Modified Davis grading: 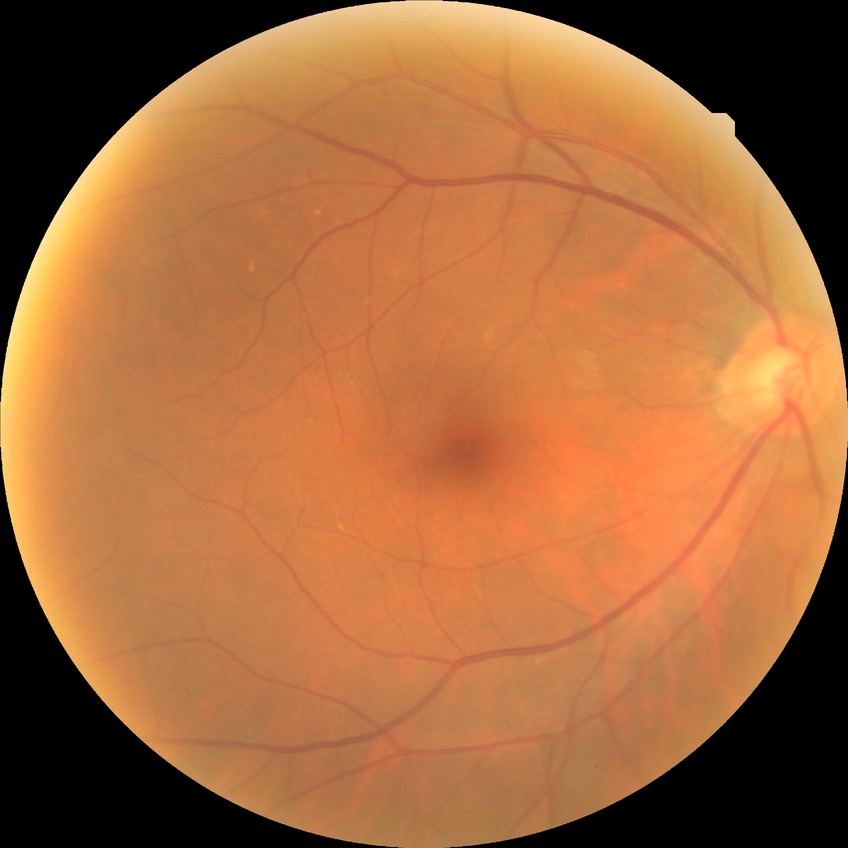 Diabetic retinopathy (DR) is NDR (no diabetic retinopathy).